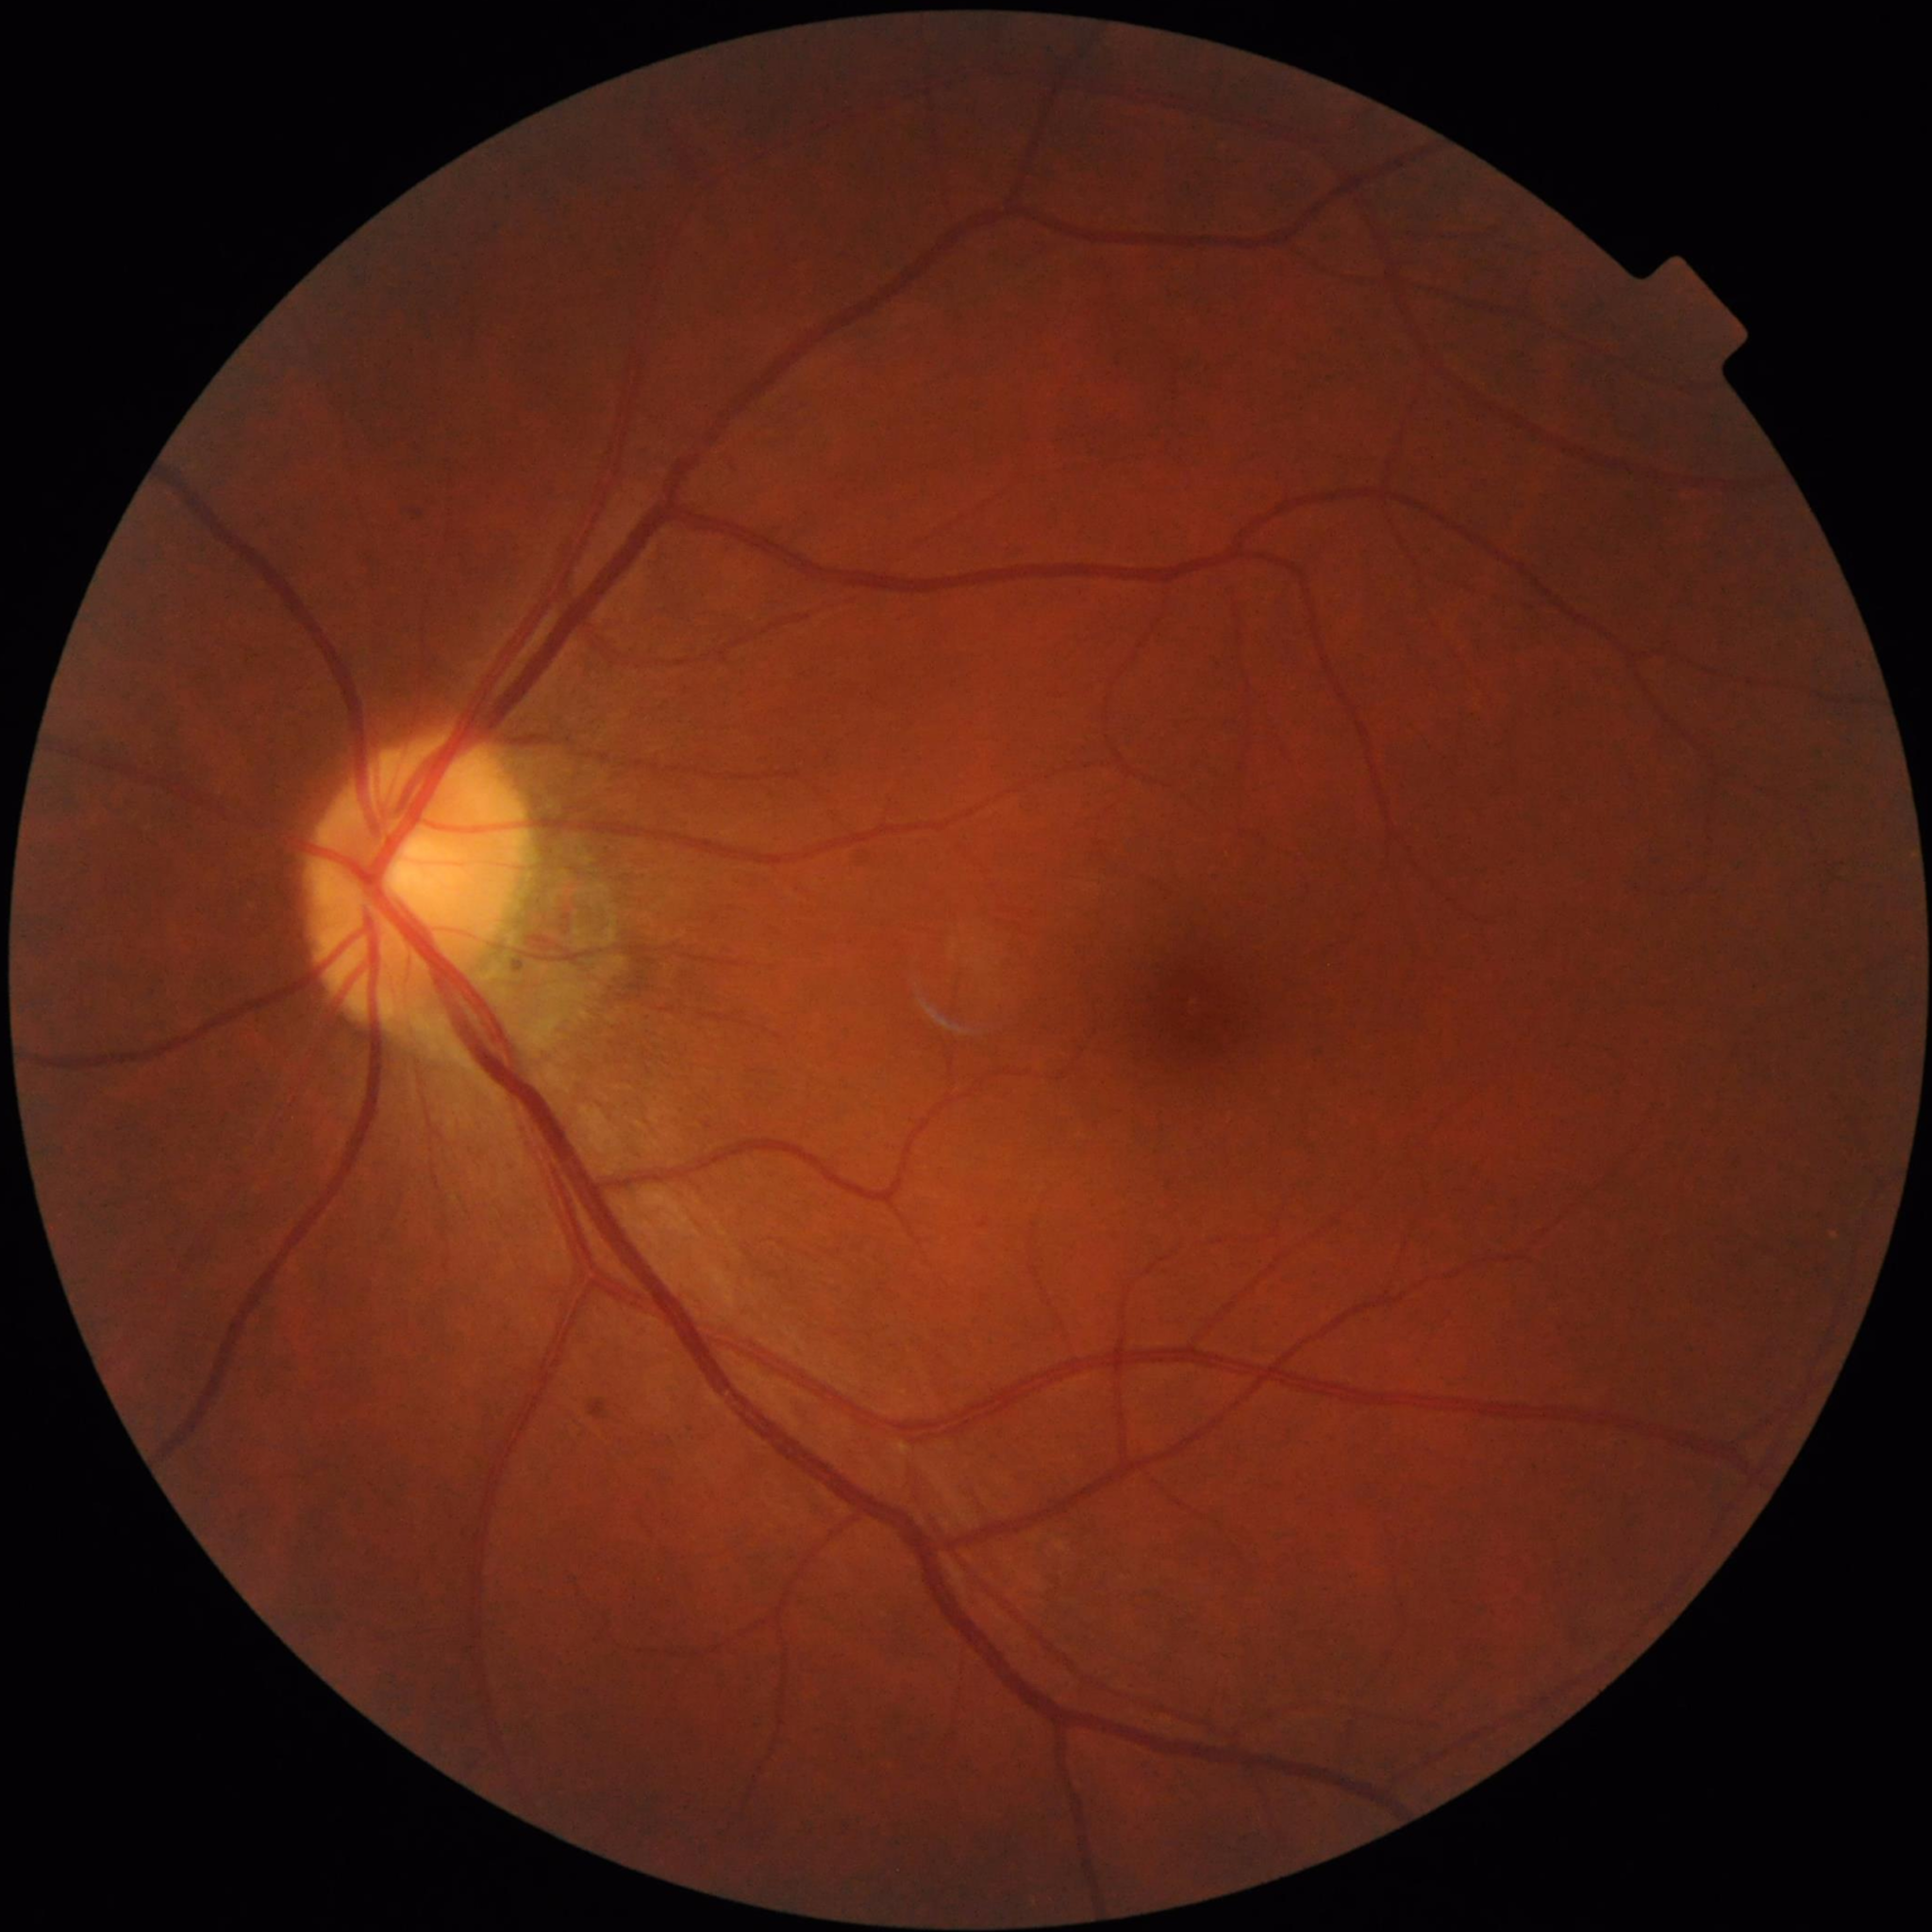
Control patient without diagnosed AMD, DR, or glaucoma.